Wide-field contact fundus photograph of an infant.
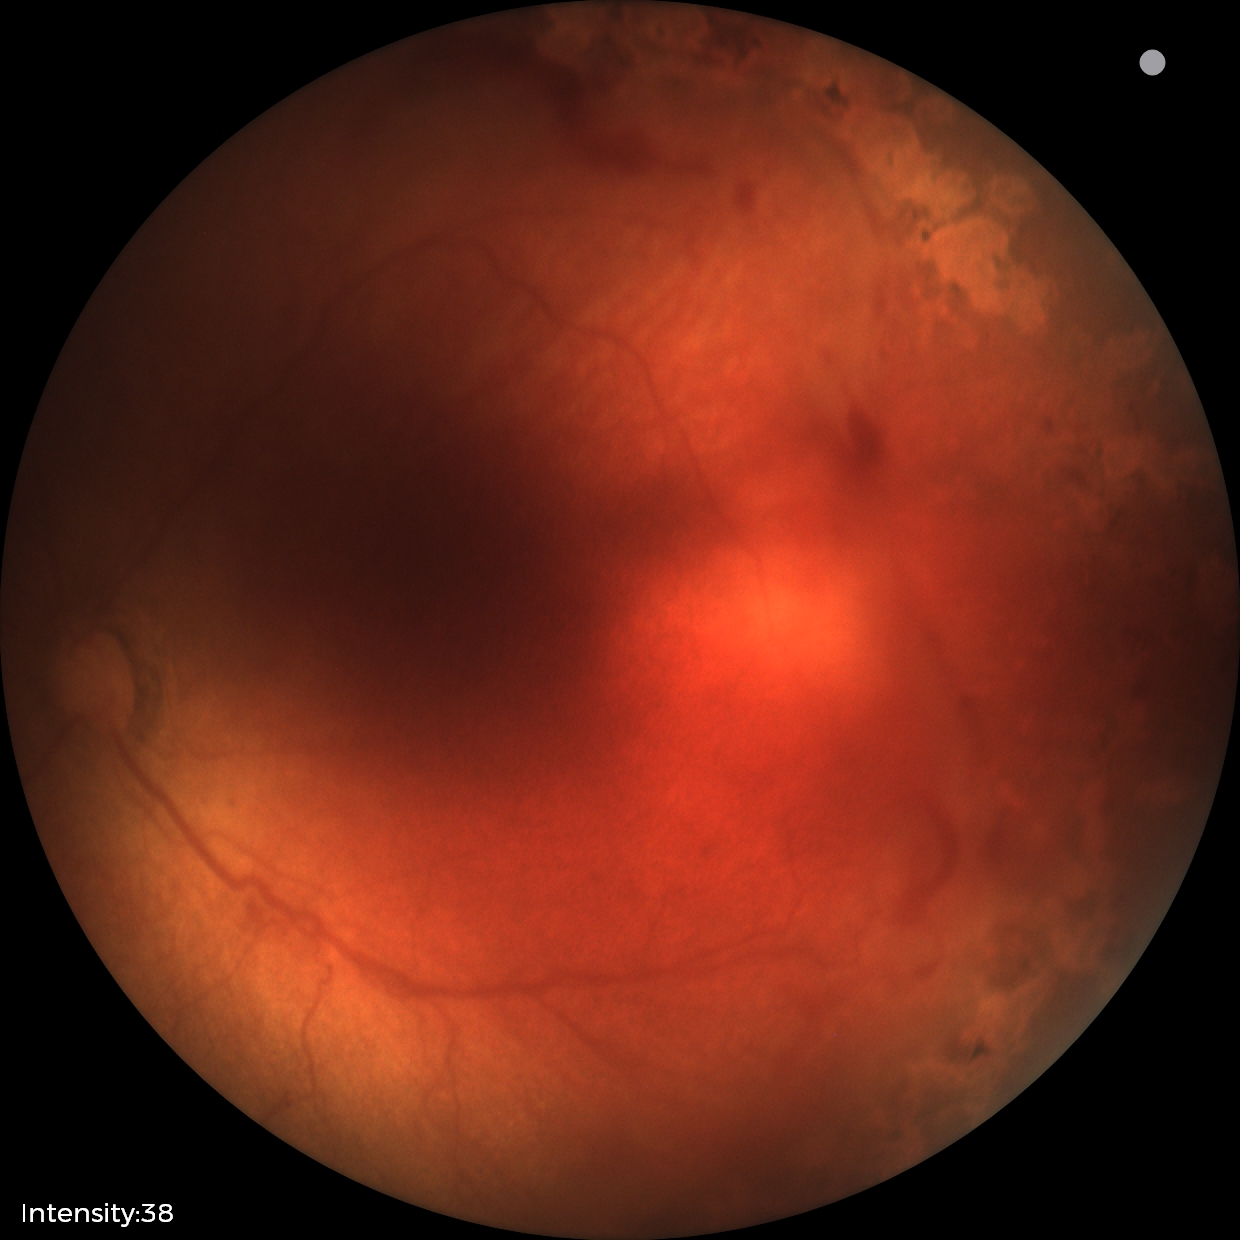 From an examination with diagnosis of status post retinopathy of prematurity.